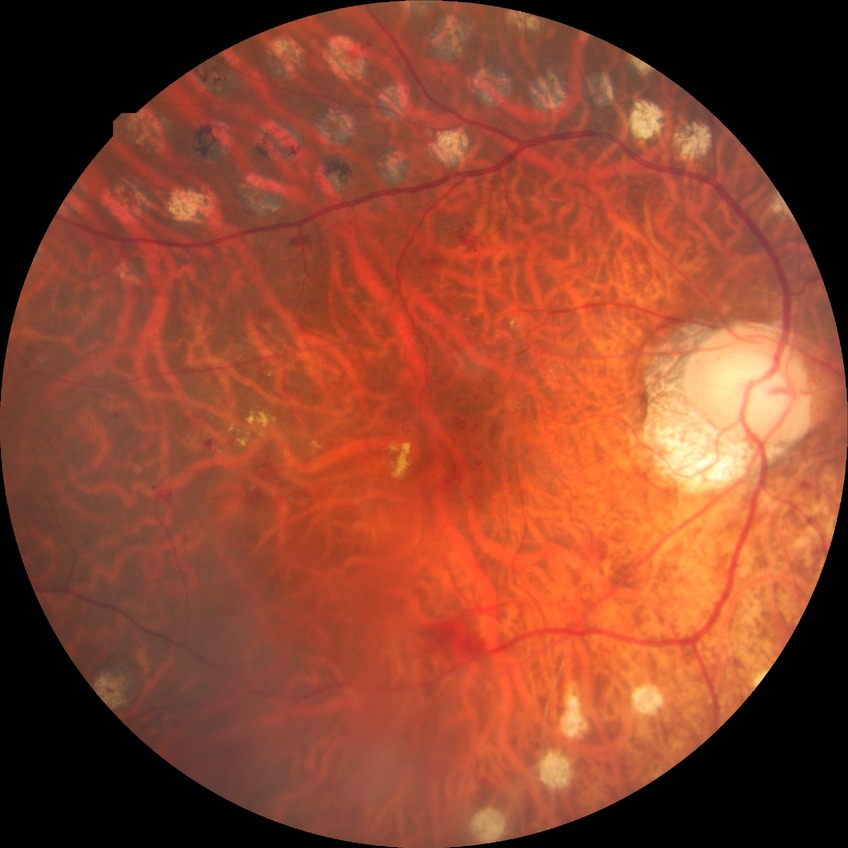

DR severity: PDR.